Retinal fundus photograph. 45-degree field of view.
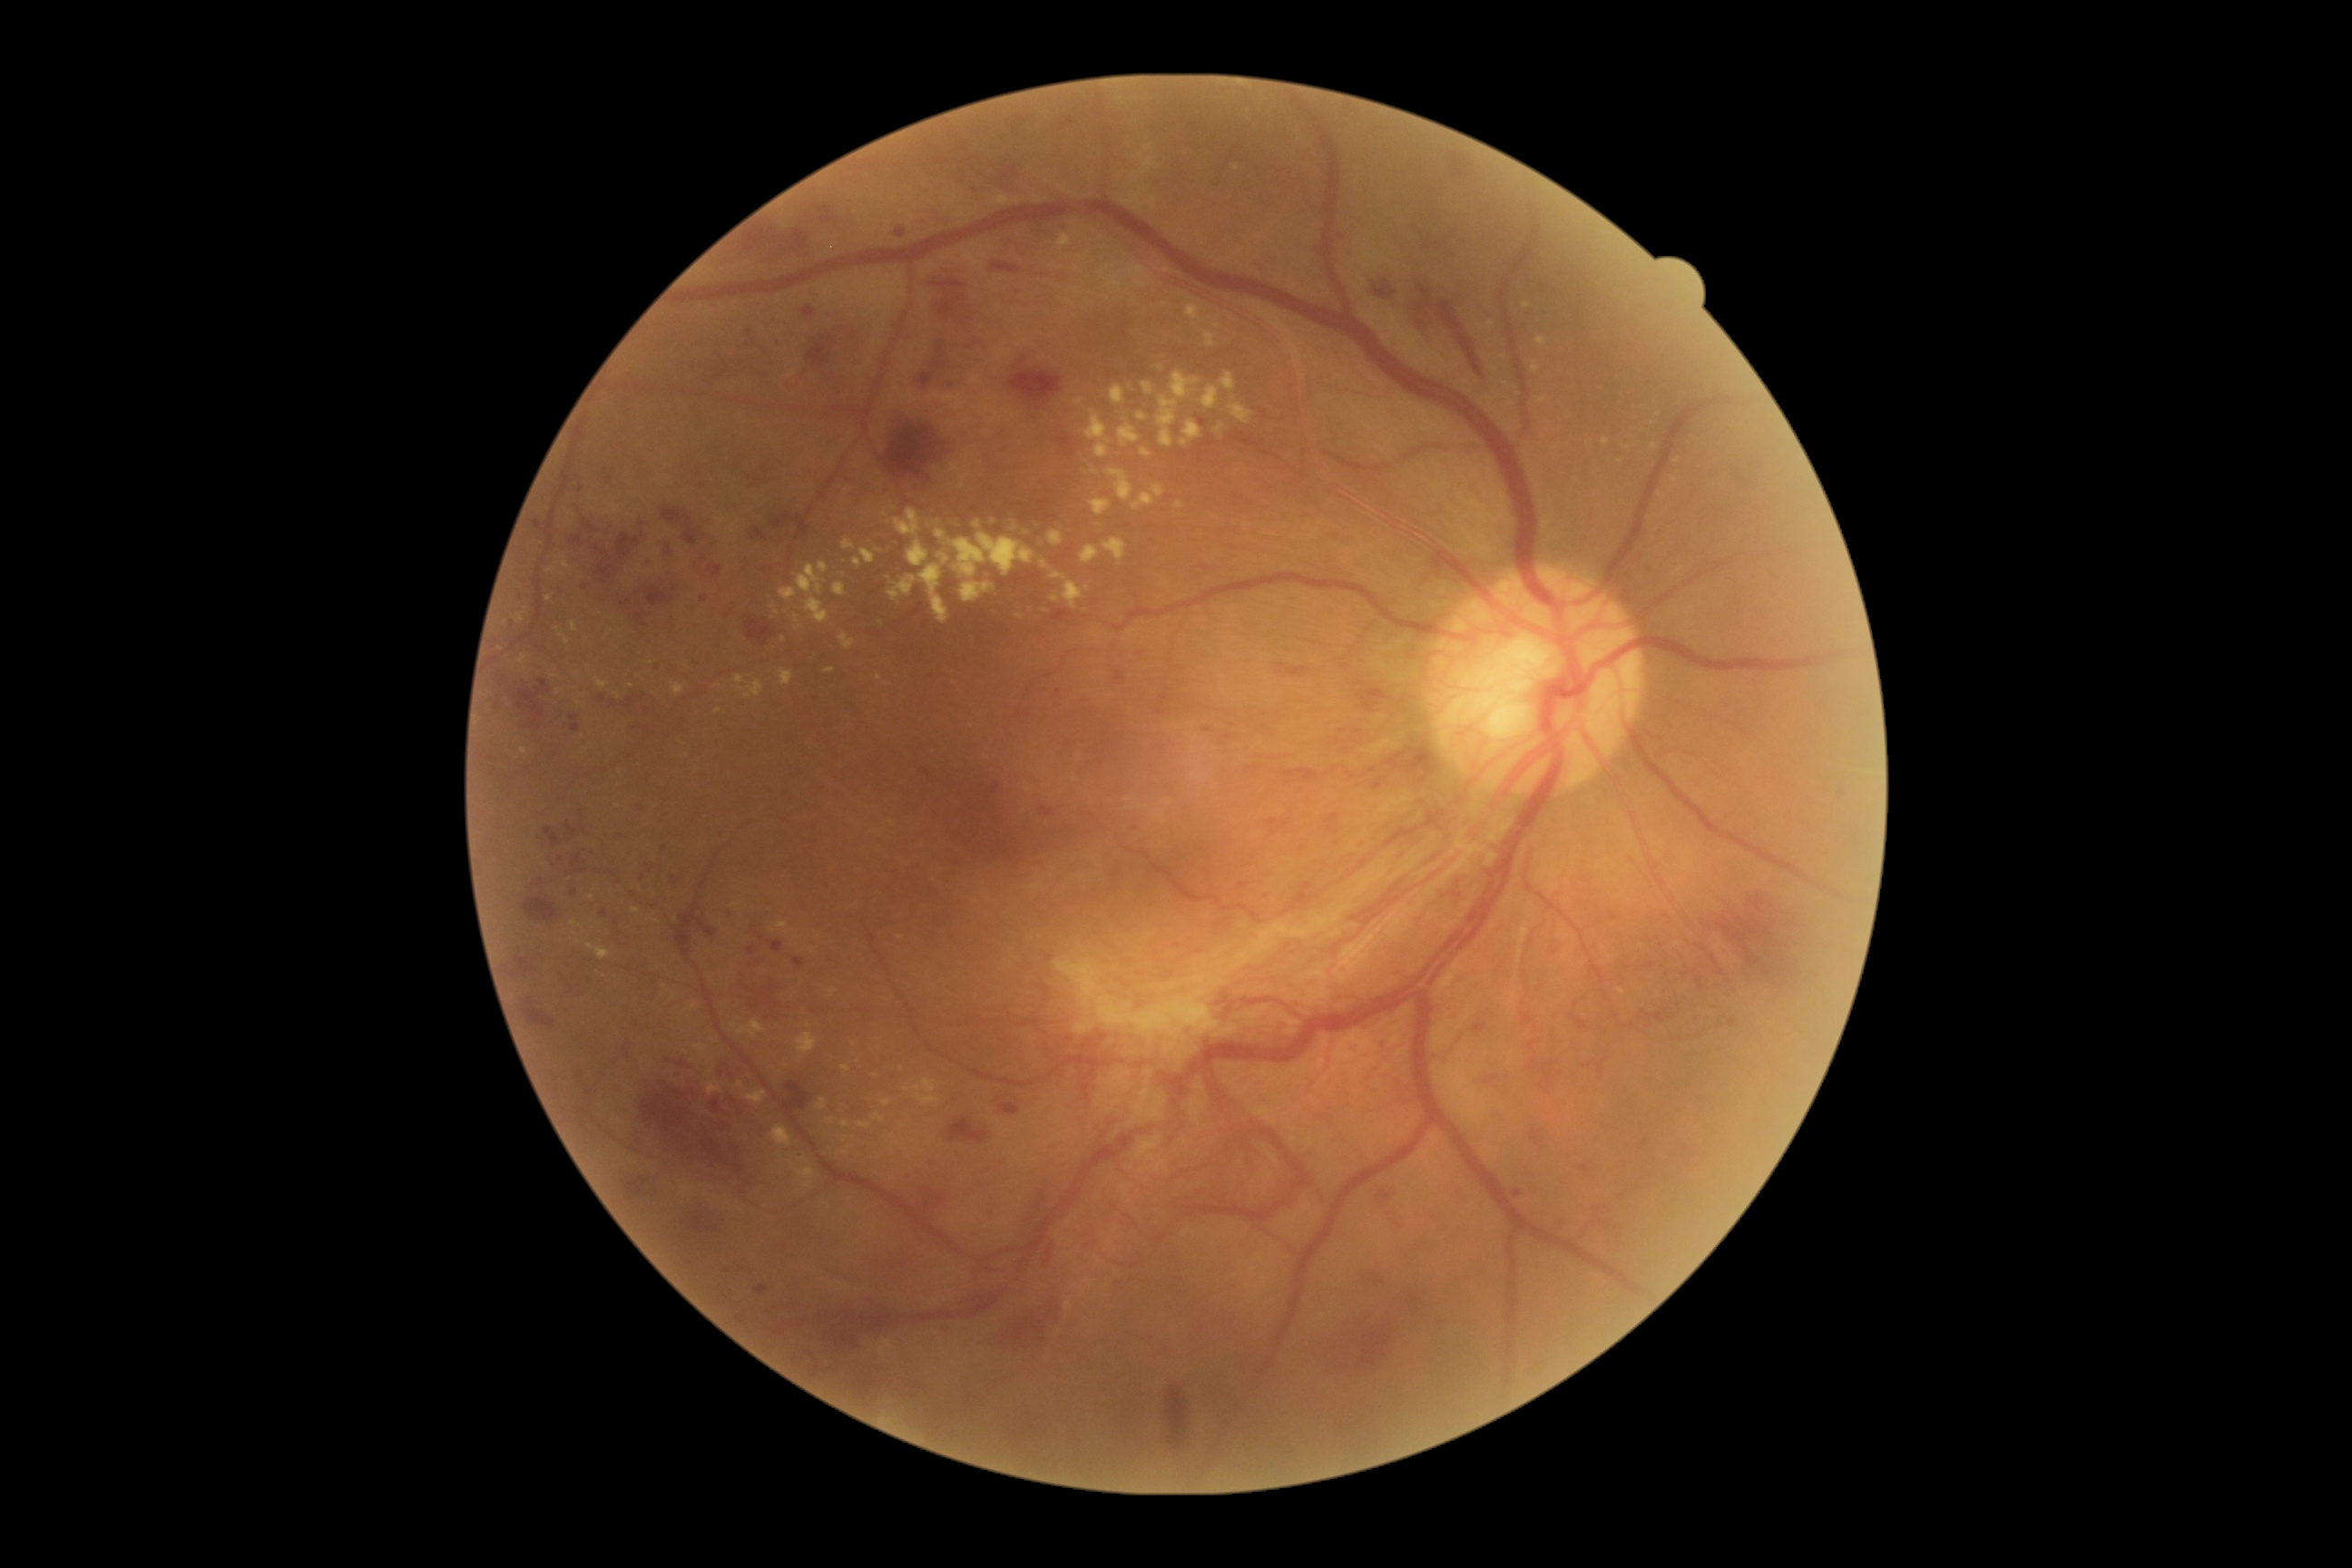

DR grade: 4
A subset of detected lesions:
EXs (subset): 959, 582, 994, 603 | 1048, 531, 1064, 547 | 1531, 362, 1540, 375 | 834, 583, 847, 598 | 1041, 562, 1050, 569 | 732, 903, 740, 908 | 571, 921, 582, 928 | 738, 1021, 767, 1039 | 1081, 545, 1101, 564 | 1142, 382, 1153, 395 | 794, 614, 798, 623 | 1124, 798, 1133, 808
Additional small EXs near [576,934] | [1658,414] | [972,727] | [878,551] | [1527,305] | [845,1139]